Image size 640x480 · infant wide-field retinal image — 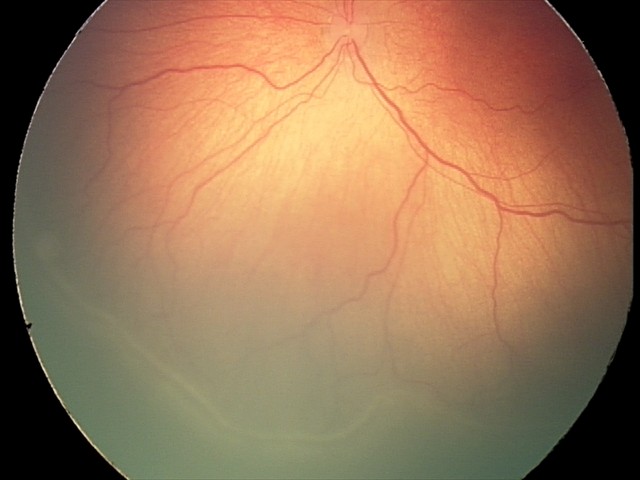 Screening series with ROP stage 2.